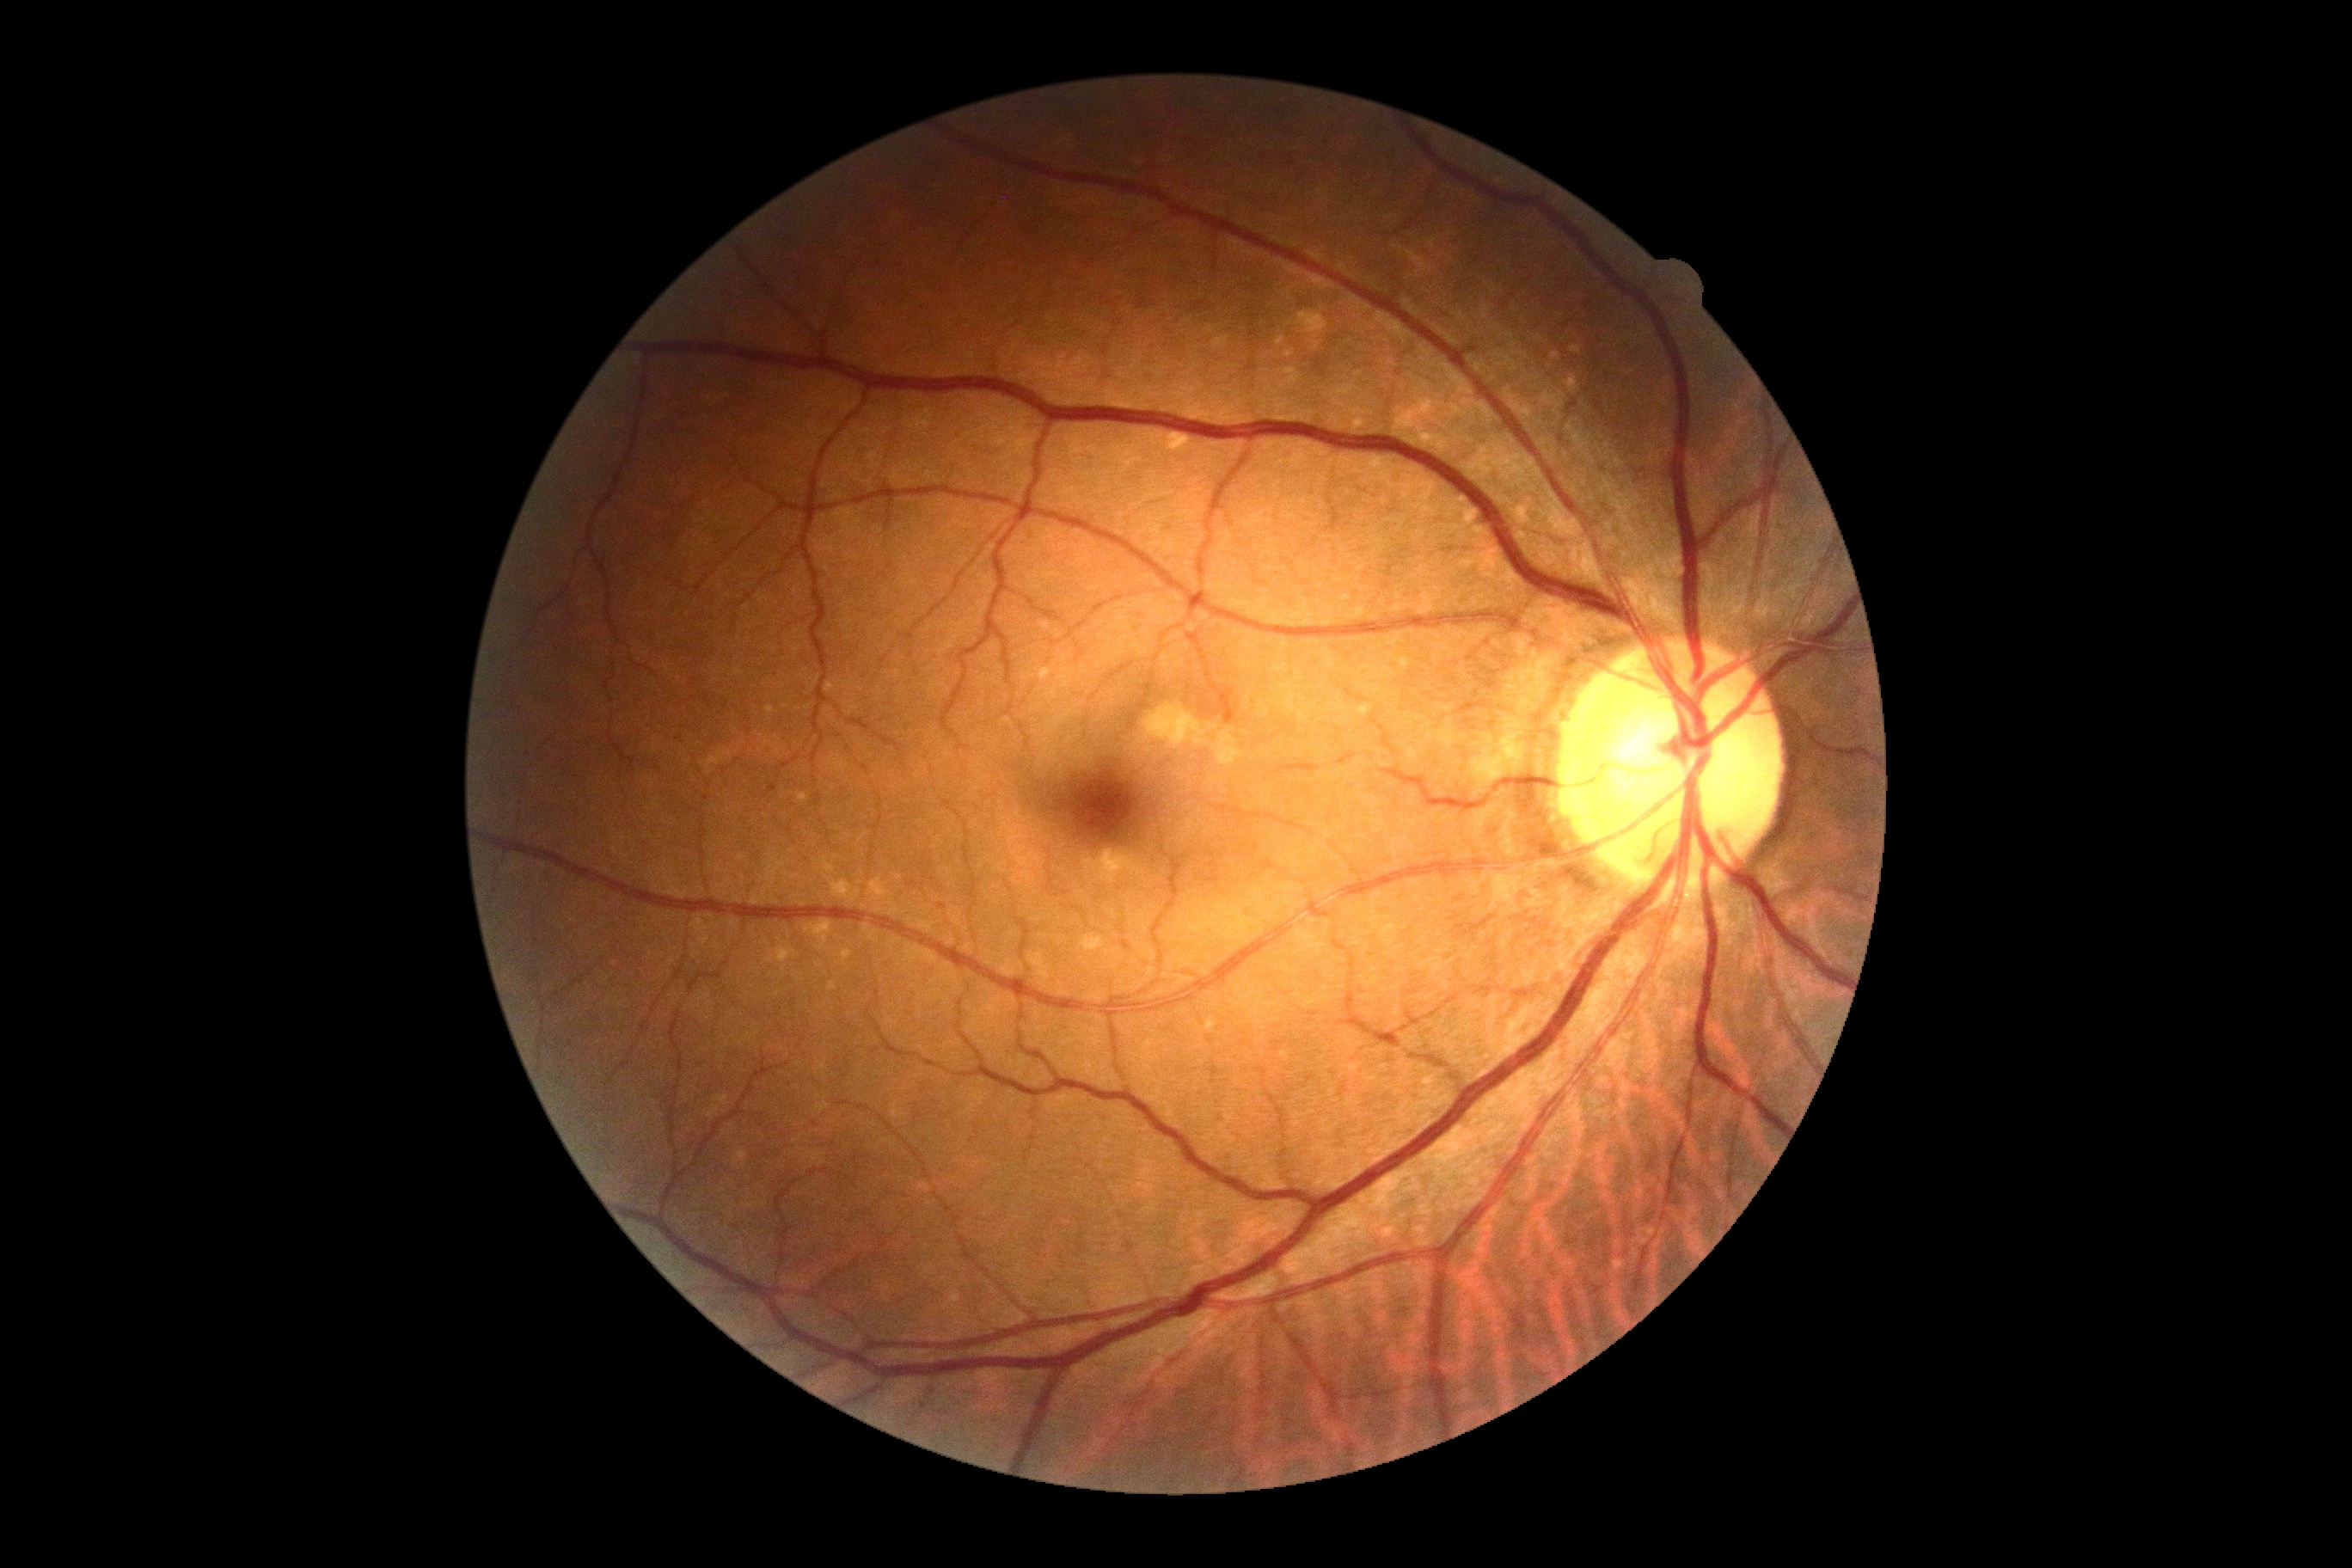 {"dr_impression": "negative for DR", "dr_grade": "grade 0"}